Color fundus image — 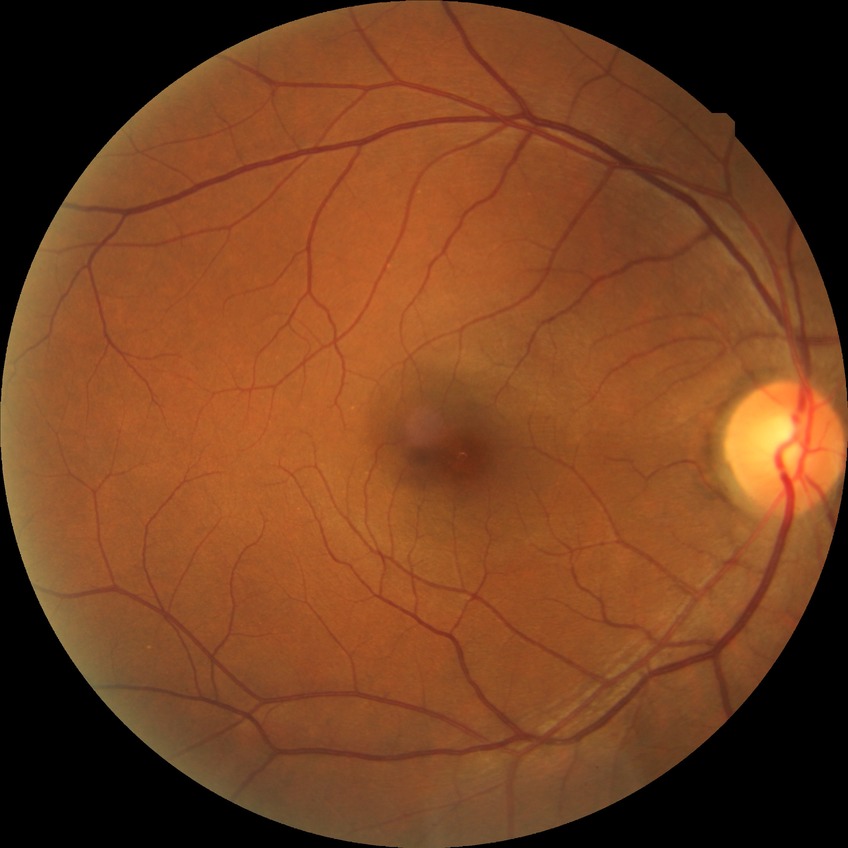
diabetic retinopathy (DR) = NDR (no diabetic retinopathy).